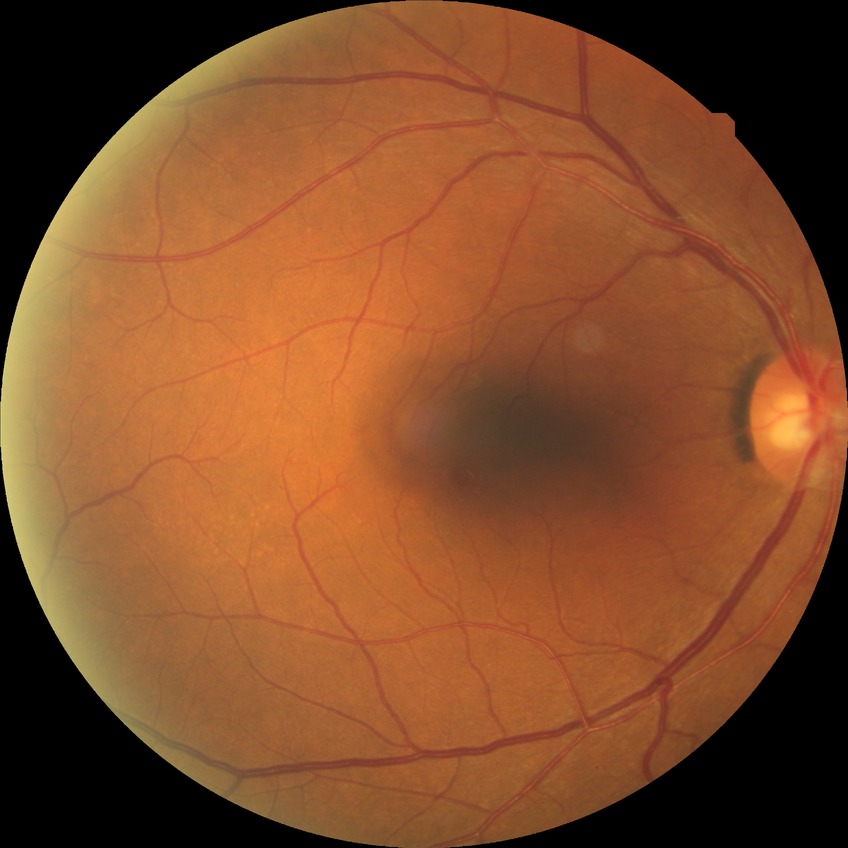

Annotations:
* DR: NDR